45° FOV, 2144x1424, CFP.
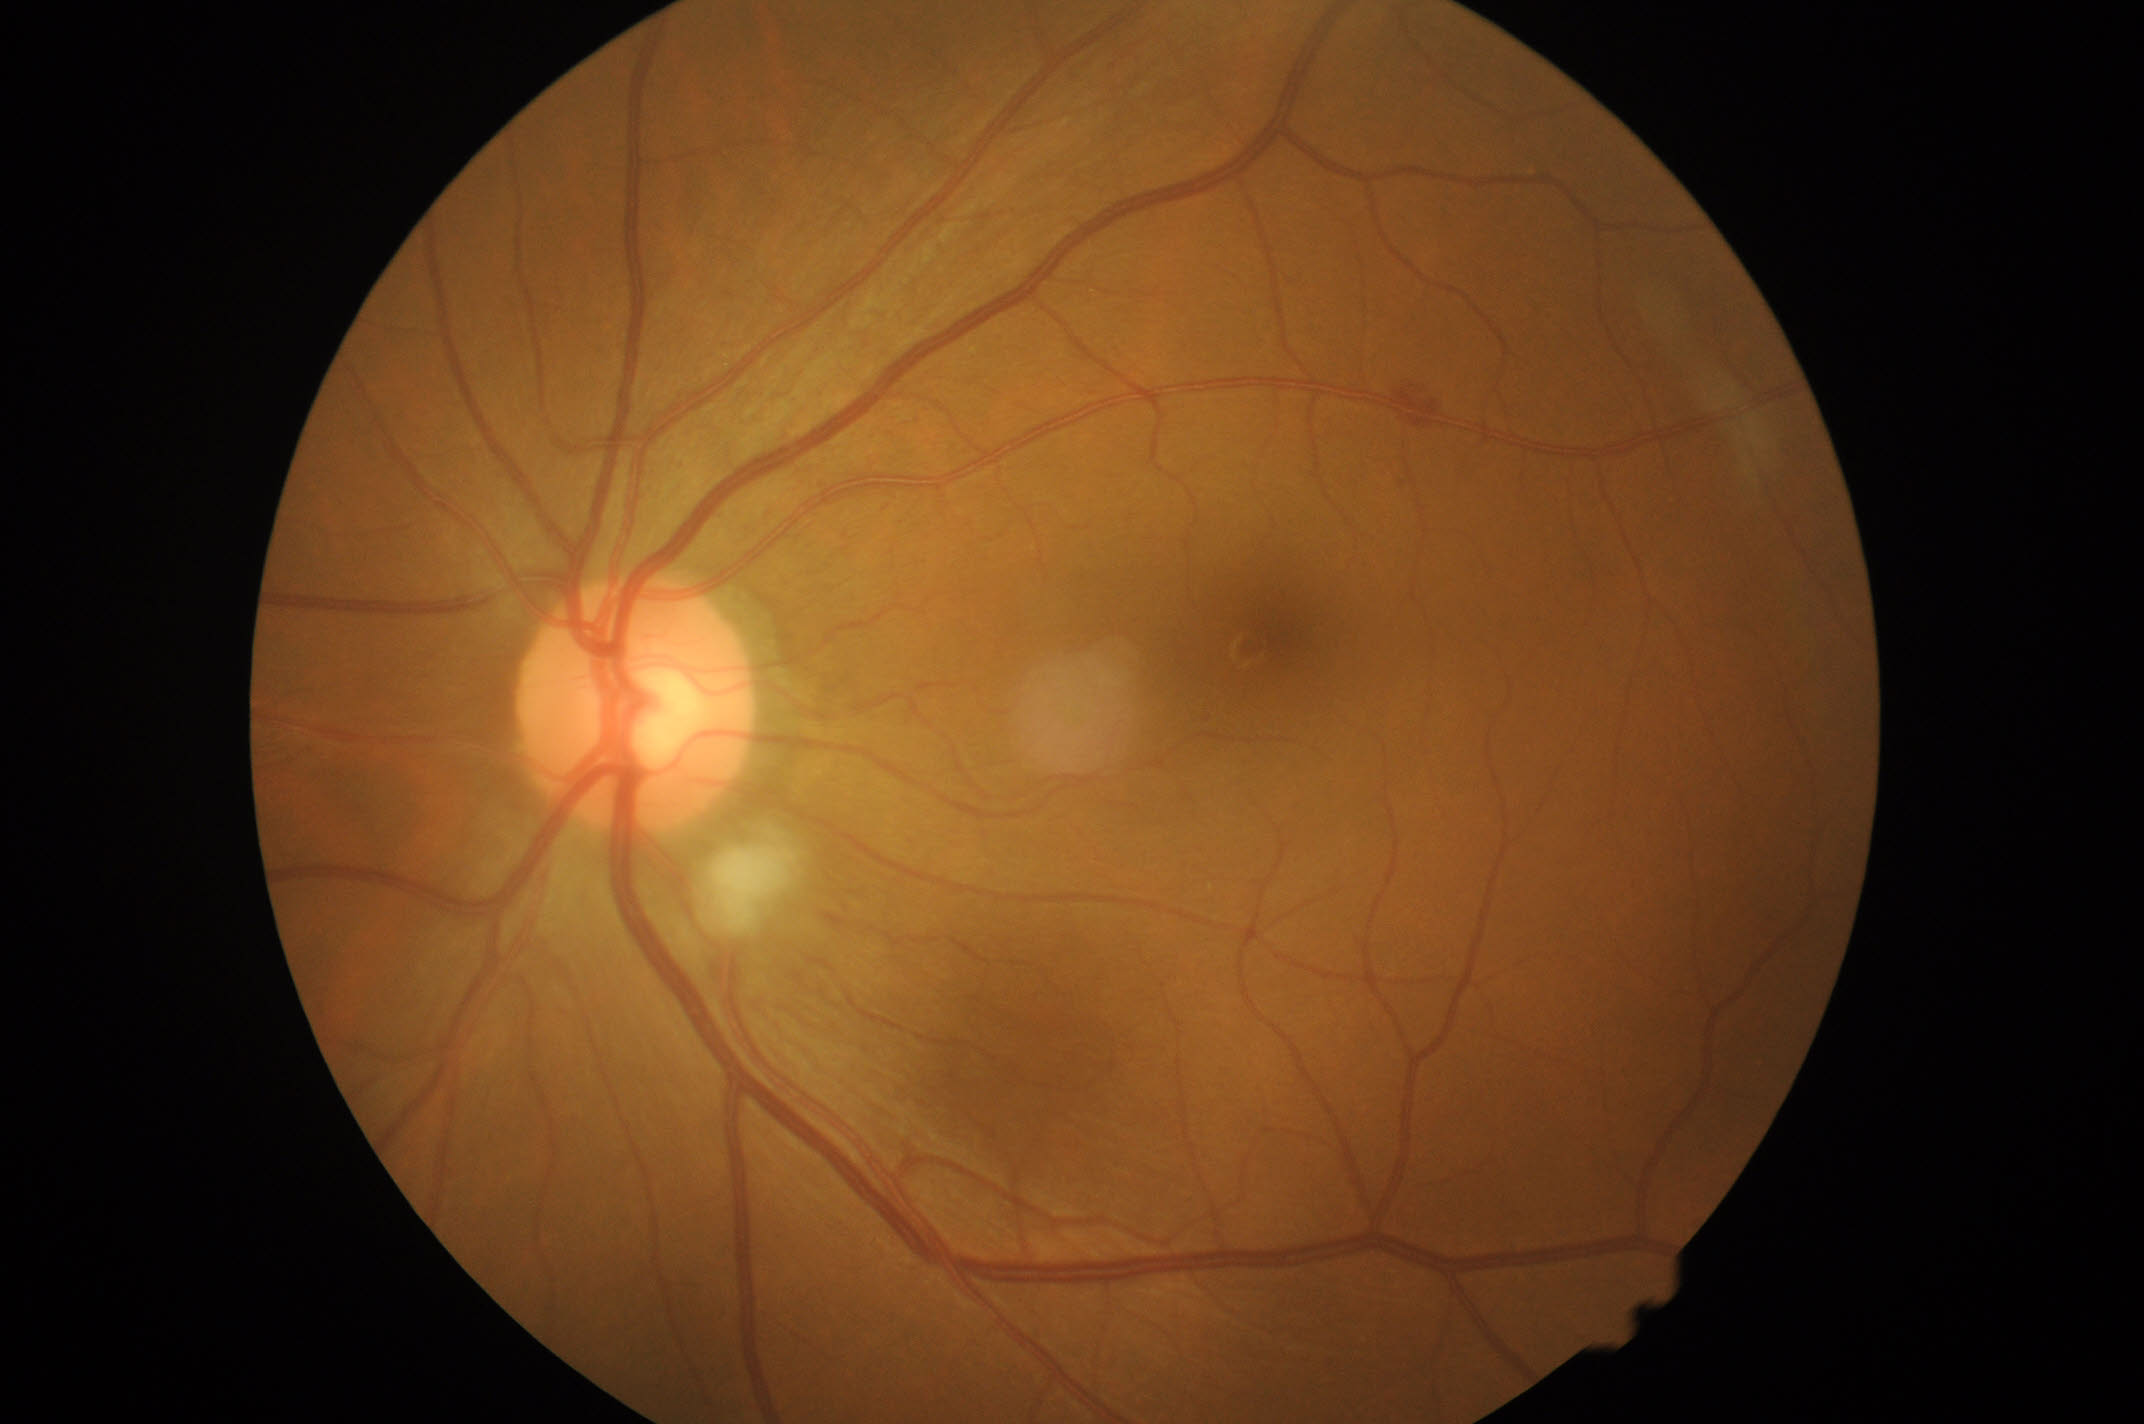

DR stage is moderate NPDR (grade 2).